Phoenix ICON wide-field infant fundus image — 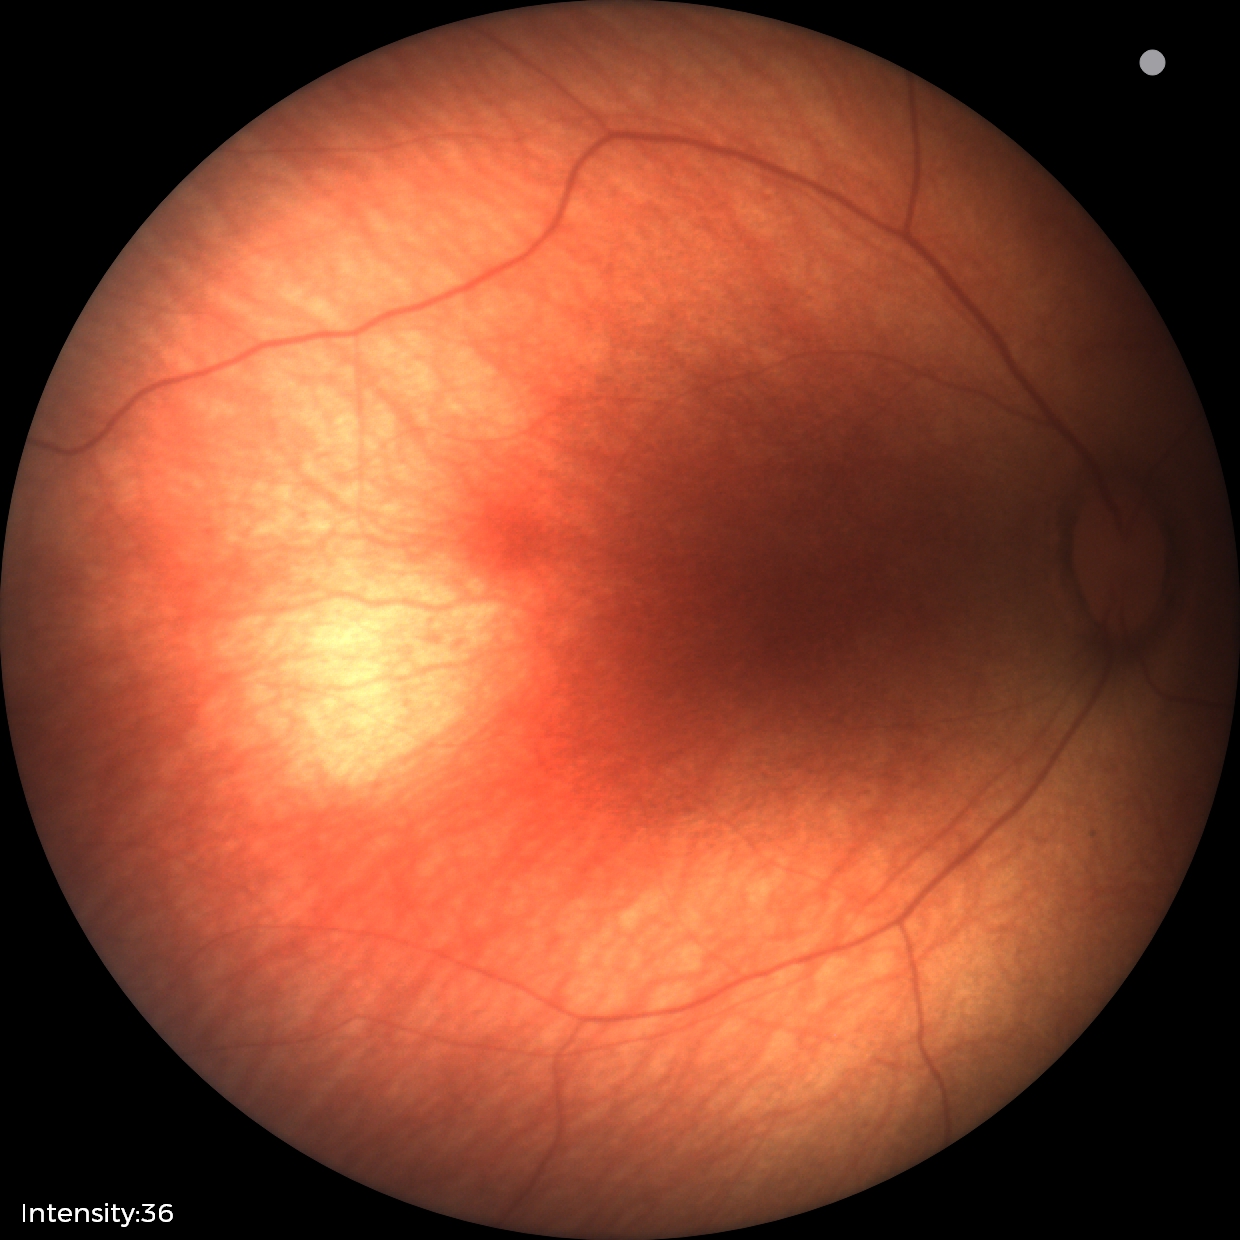
Impression: normal fundus examination.